848x848px · nonmydriatic
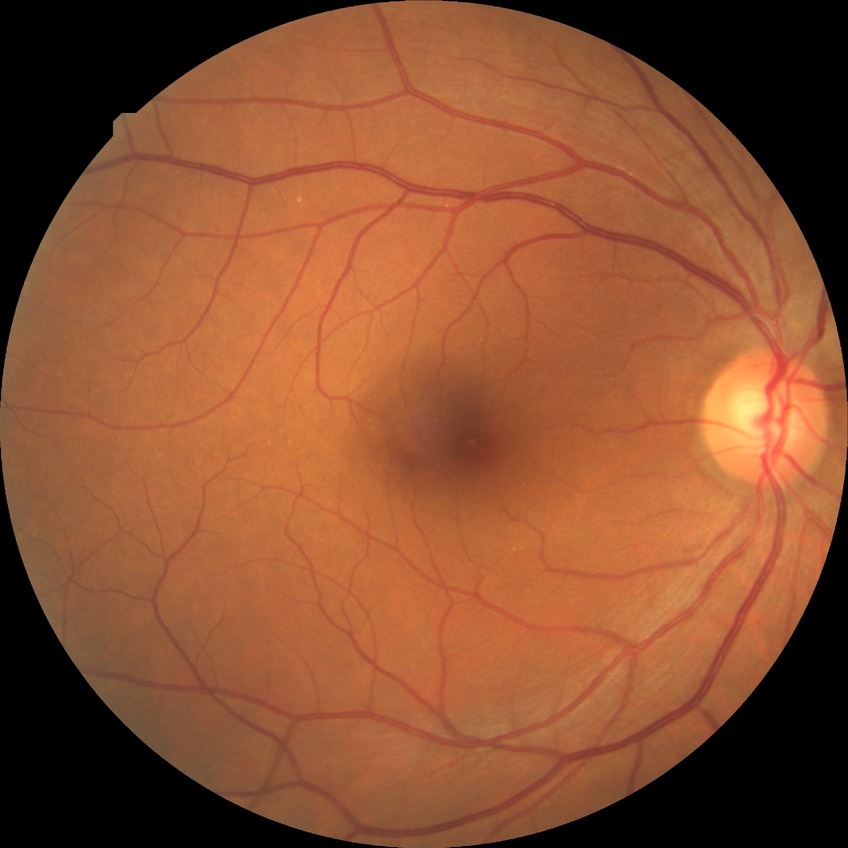
Annotations:
• modified Davis grading: no diabetic retinopathy